Natus RetCam Envision, 130° FOV. Pediatric retinal photograph (wide-field) — 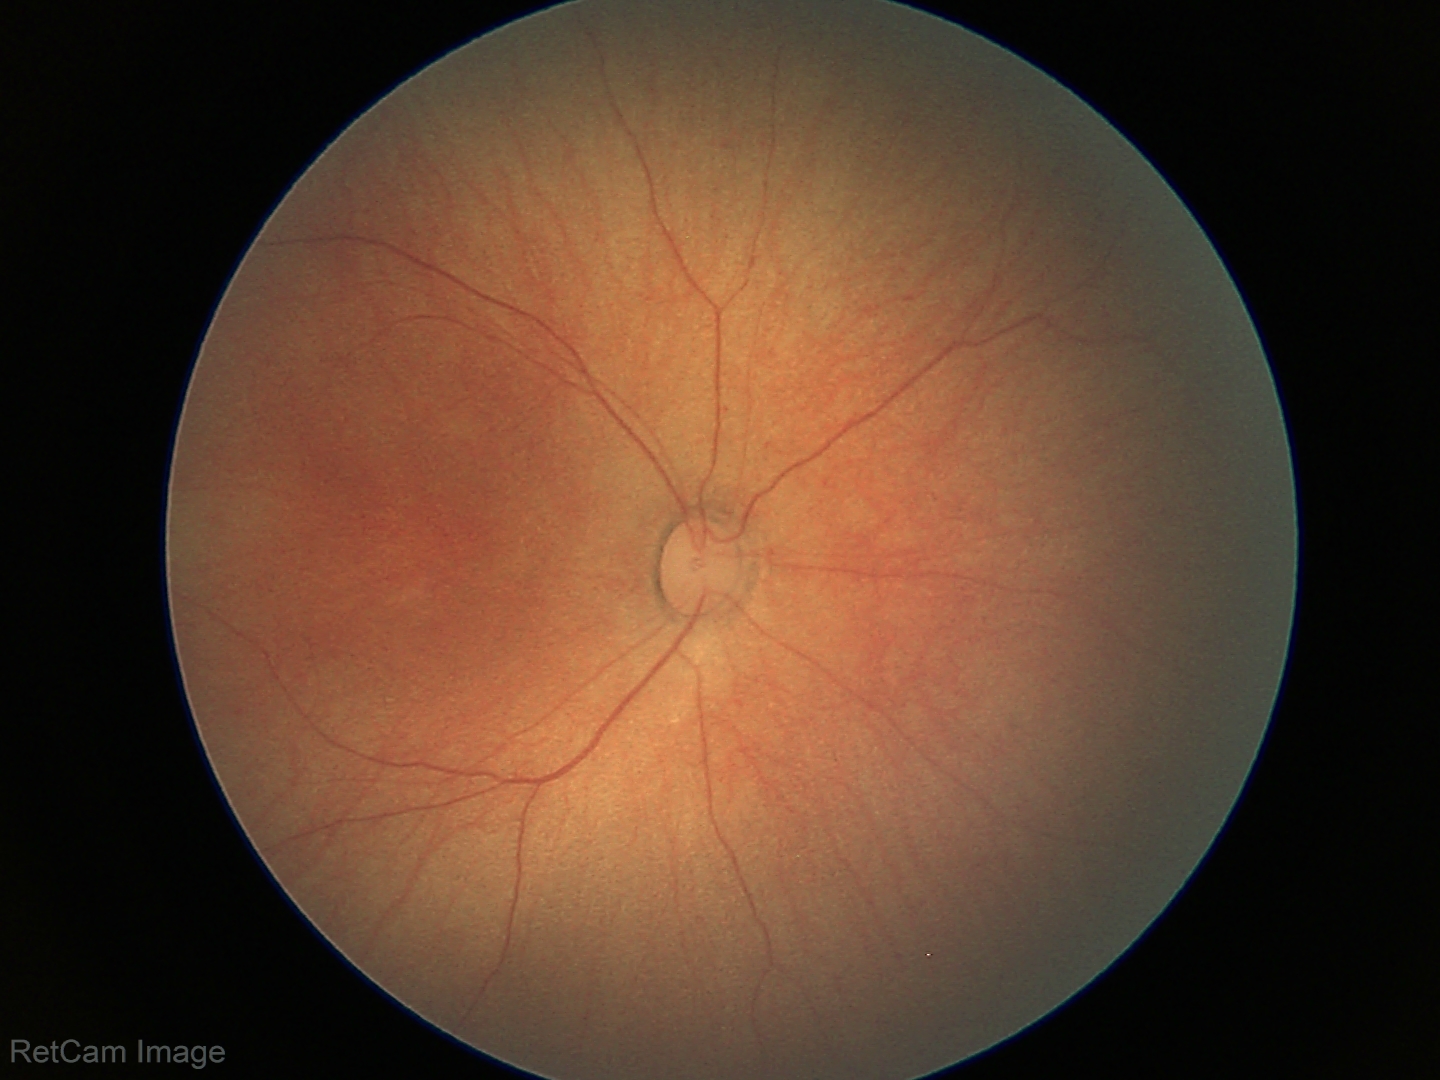

Finding: physiological.